Camera: Nidek AFC-330.
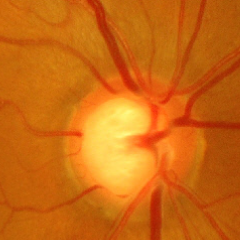

There is evidence of advanced-stage glaucoma.